Nonmydriatic; image size 848x848:
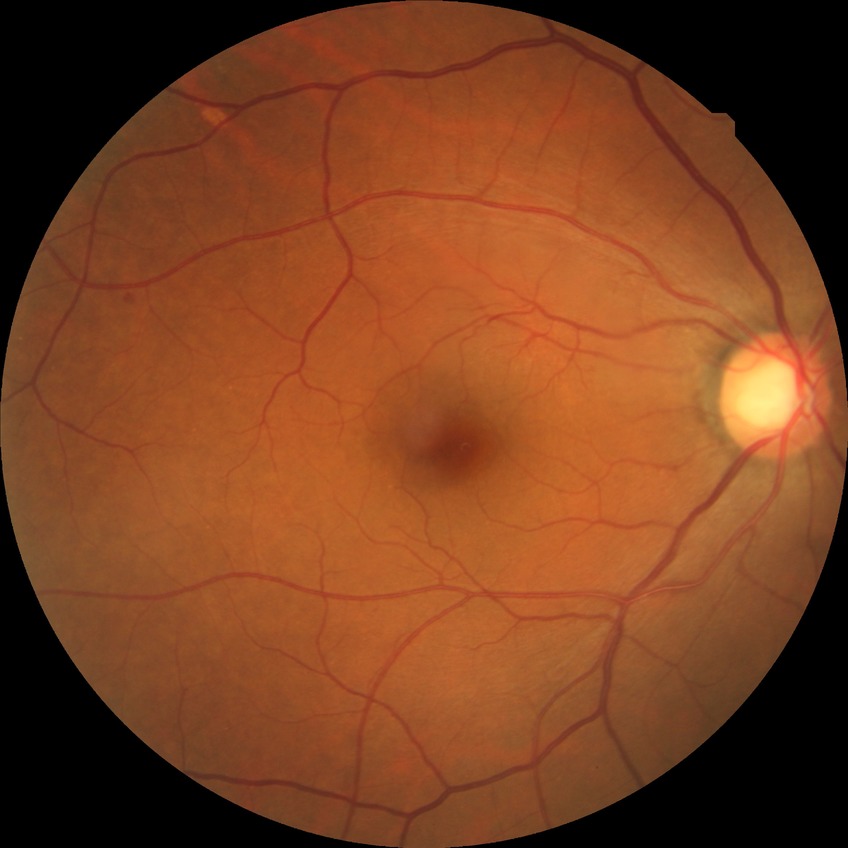
Modified Davis grading: no diabetic retinopathy.